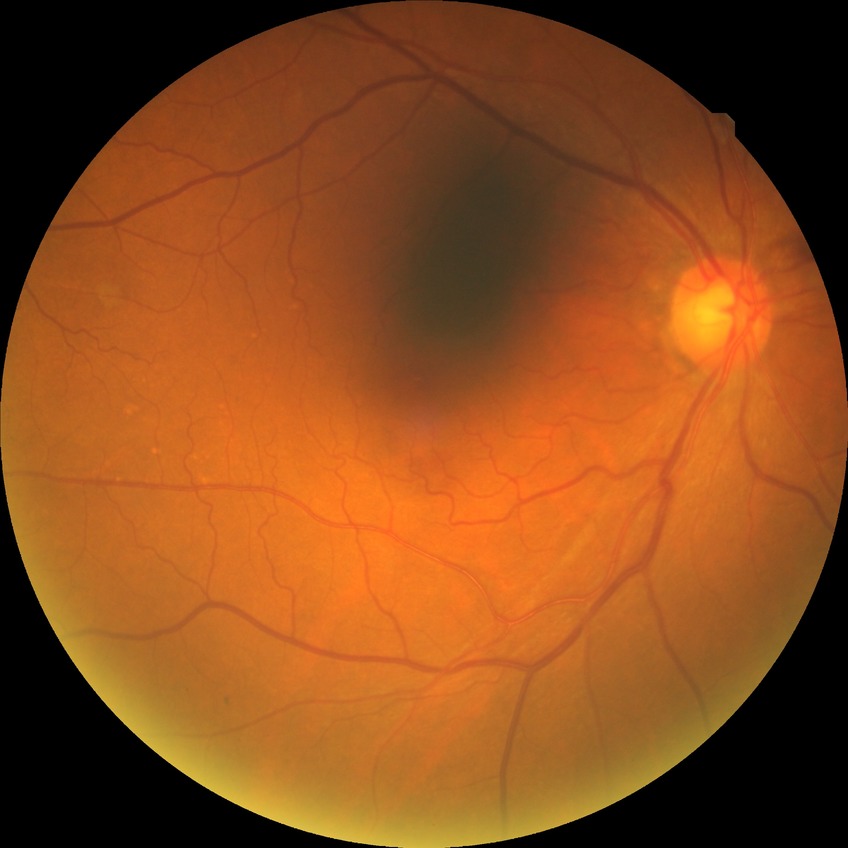
DR impression: no DR findings, DR stage: NDR.